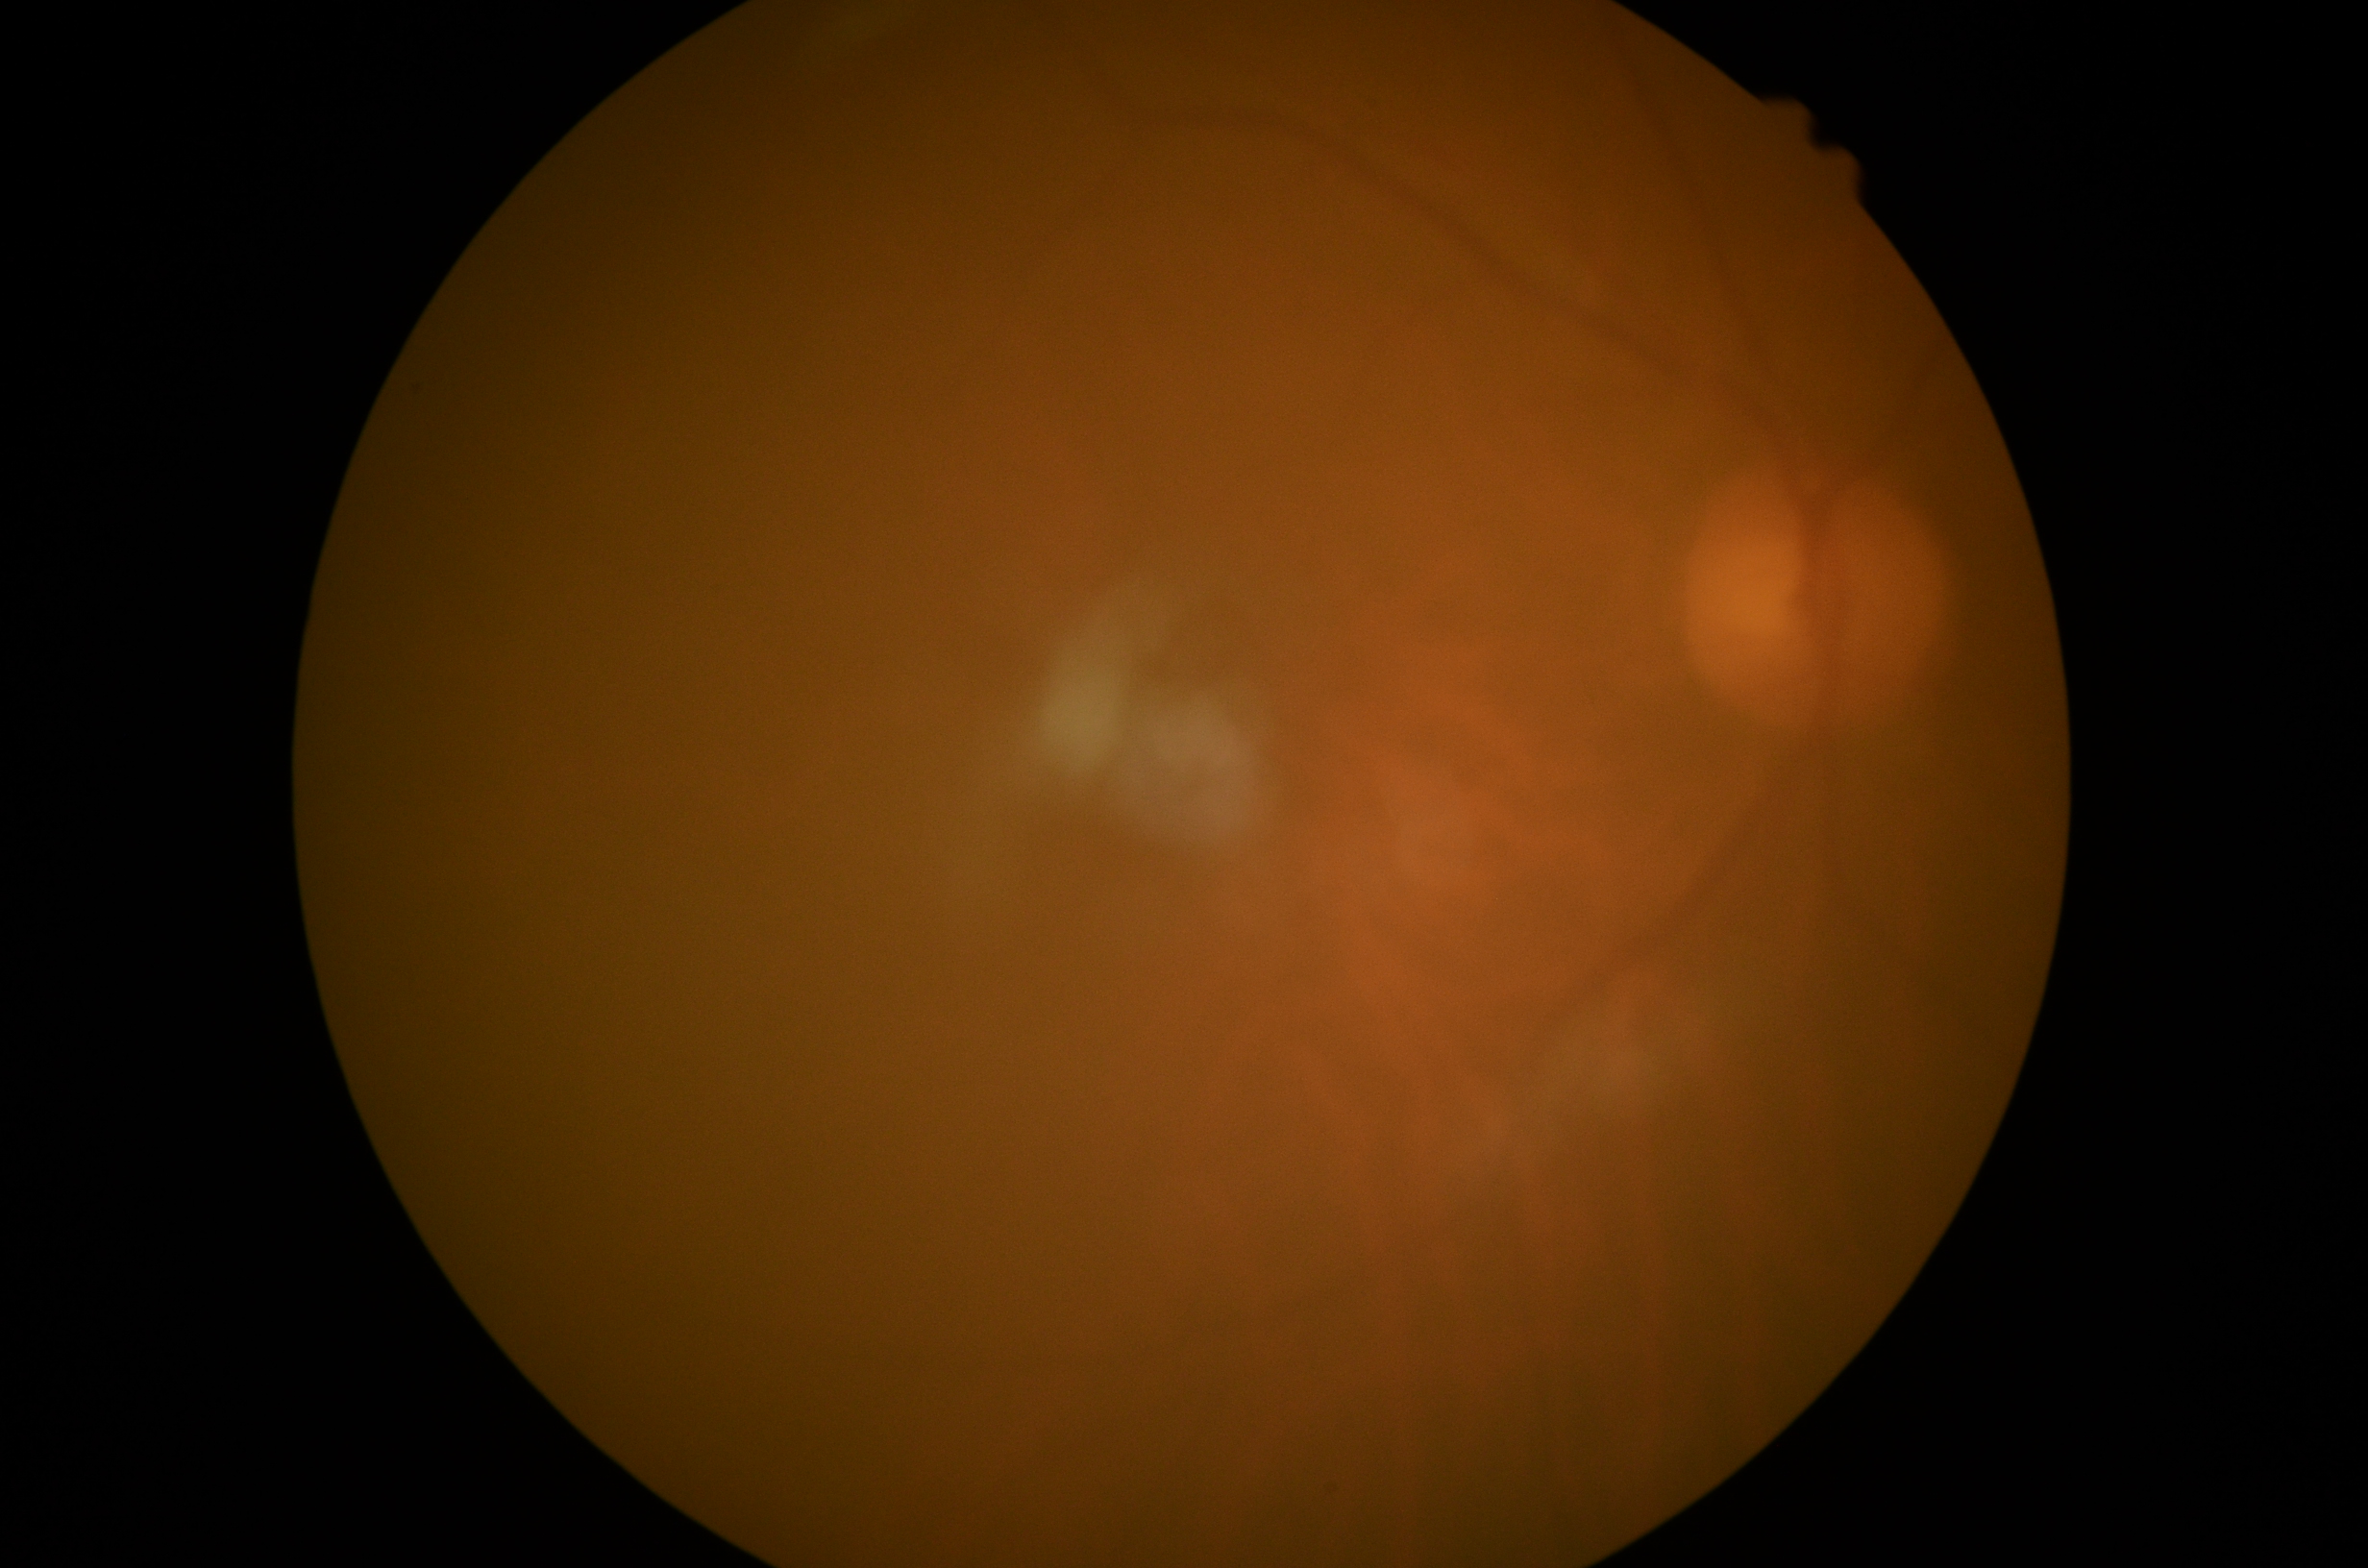

retinopathy=ungradable due to poor image quality, image quality=insufficient.